50-degree field of view; captured on a Topcon TRC-50DX fundus camera:
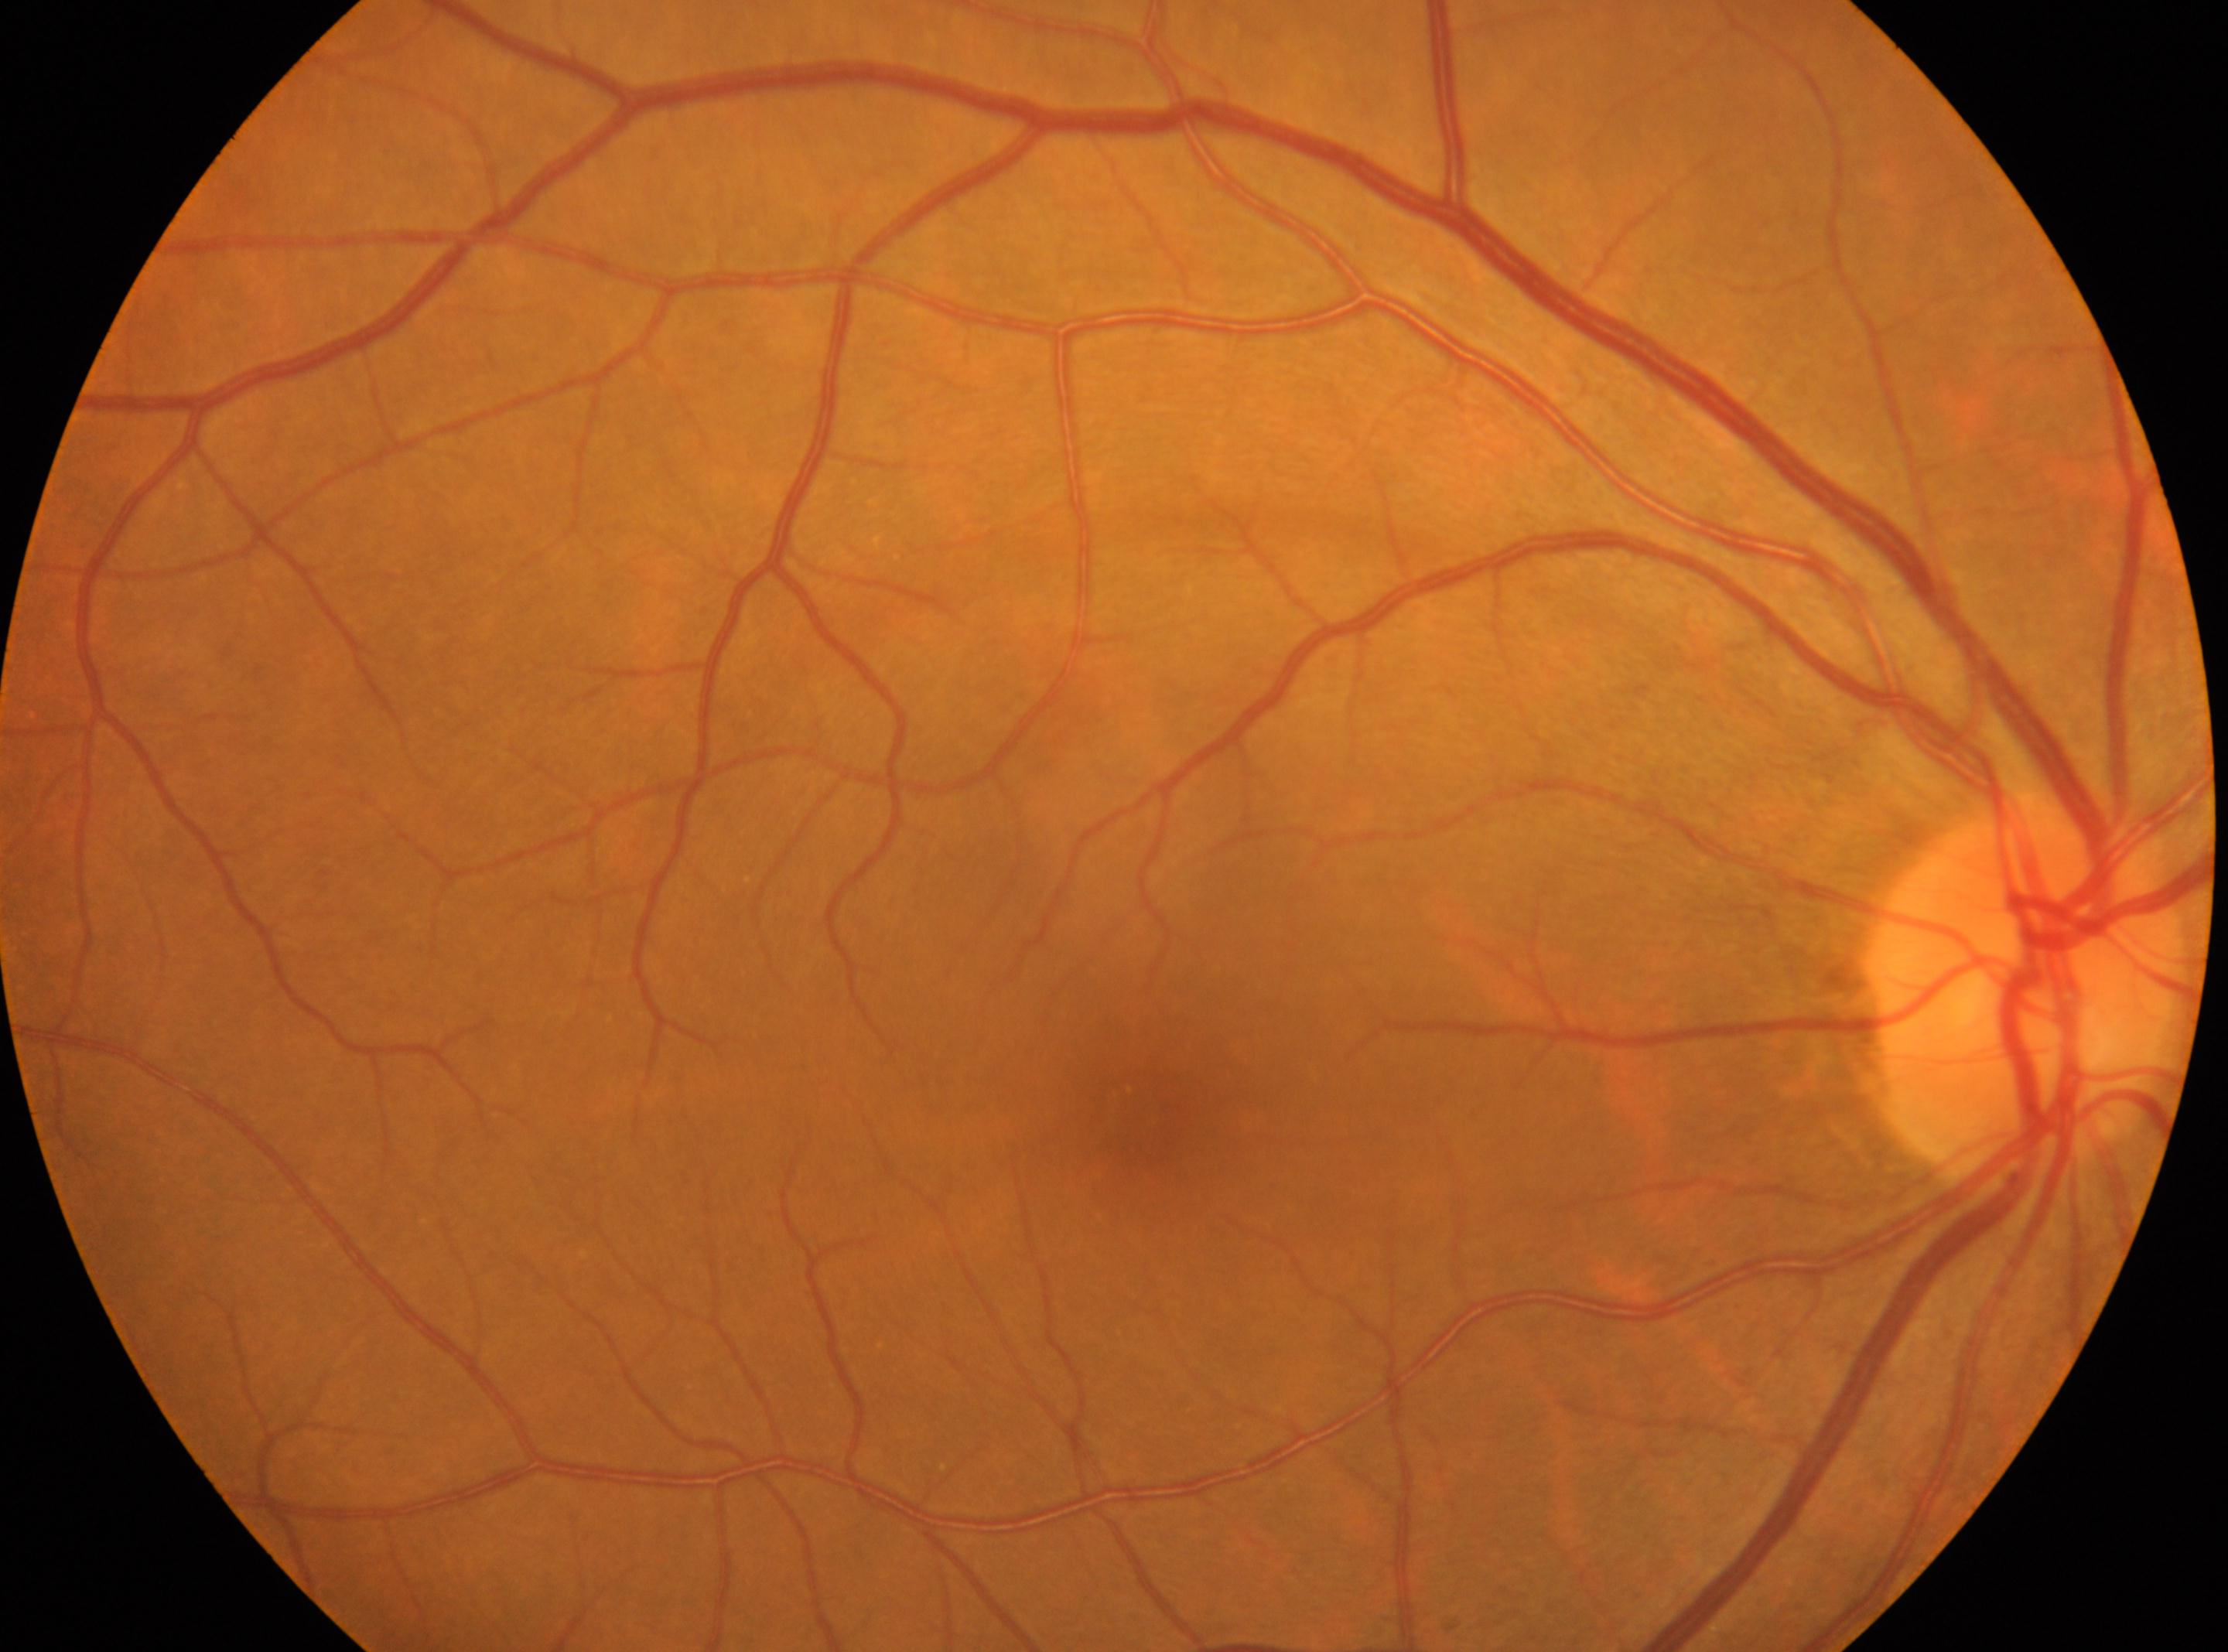 {
  "eye": "oculus dexter",
  "fovea": "(x=1148, y=1125)",
  "dr_grade": "0",
  "optic_disc": "(x=2022, y=999)"
}